Graded on the modified Davis scale · nonmydriatic fundus photograph: 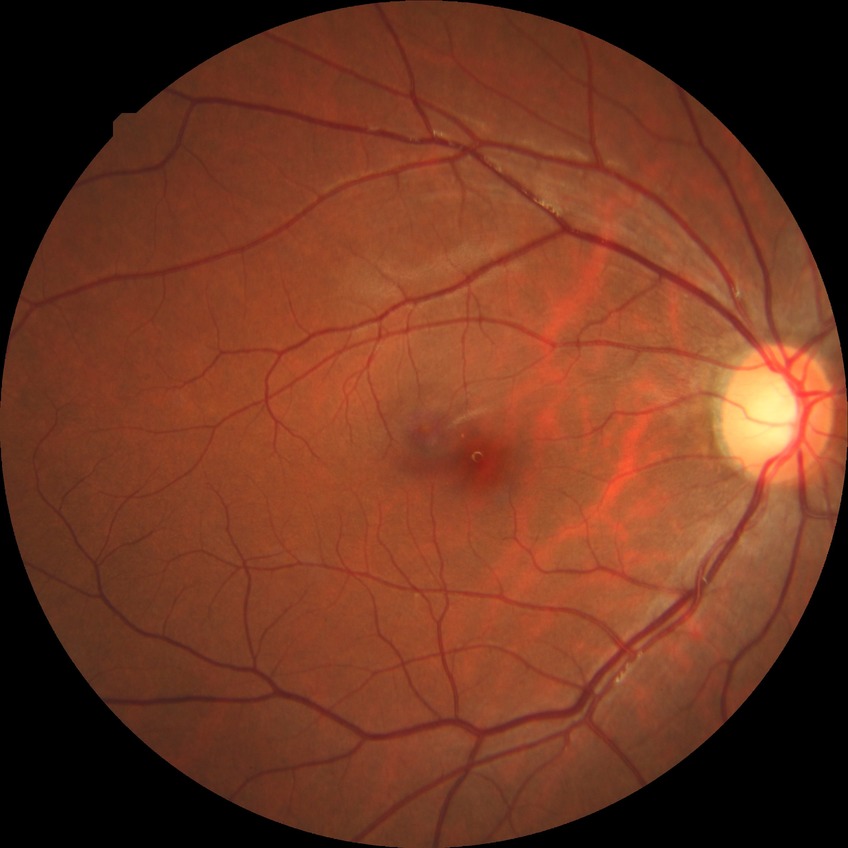 {
  "davis_grade": "NDR (no diabetic retinopathy)"
}